2102x1736: 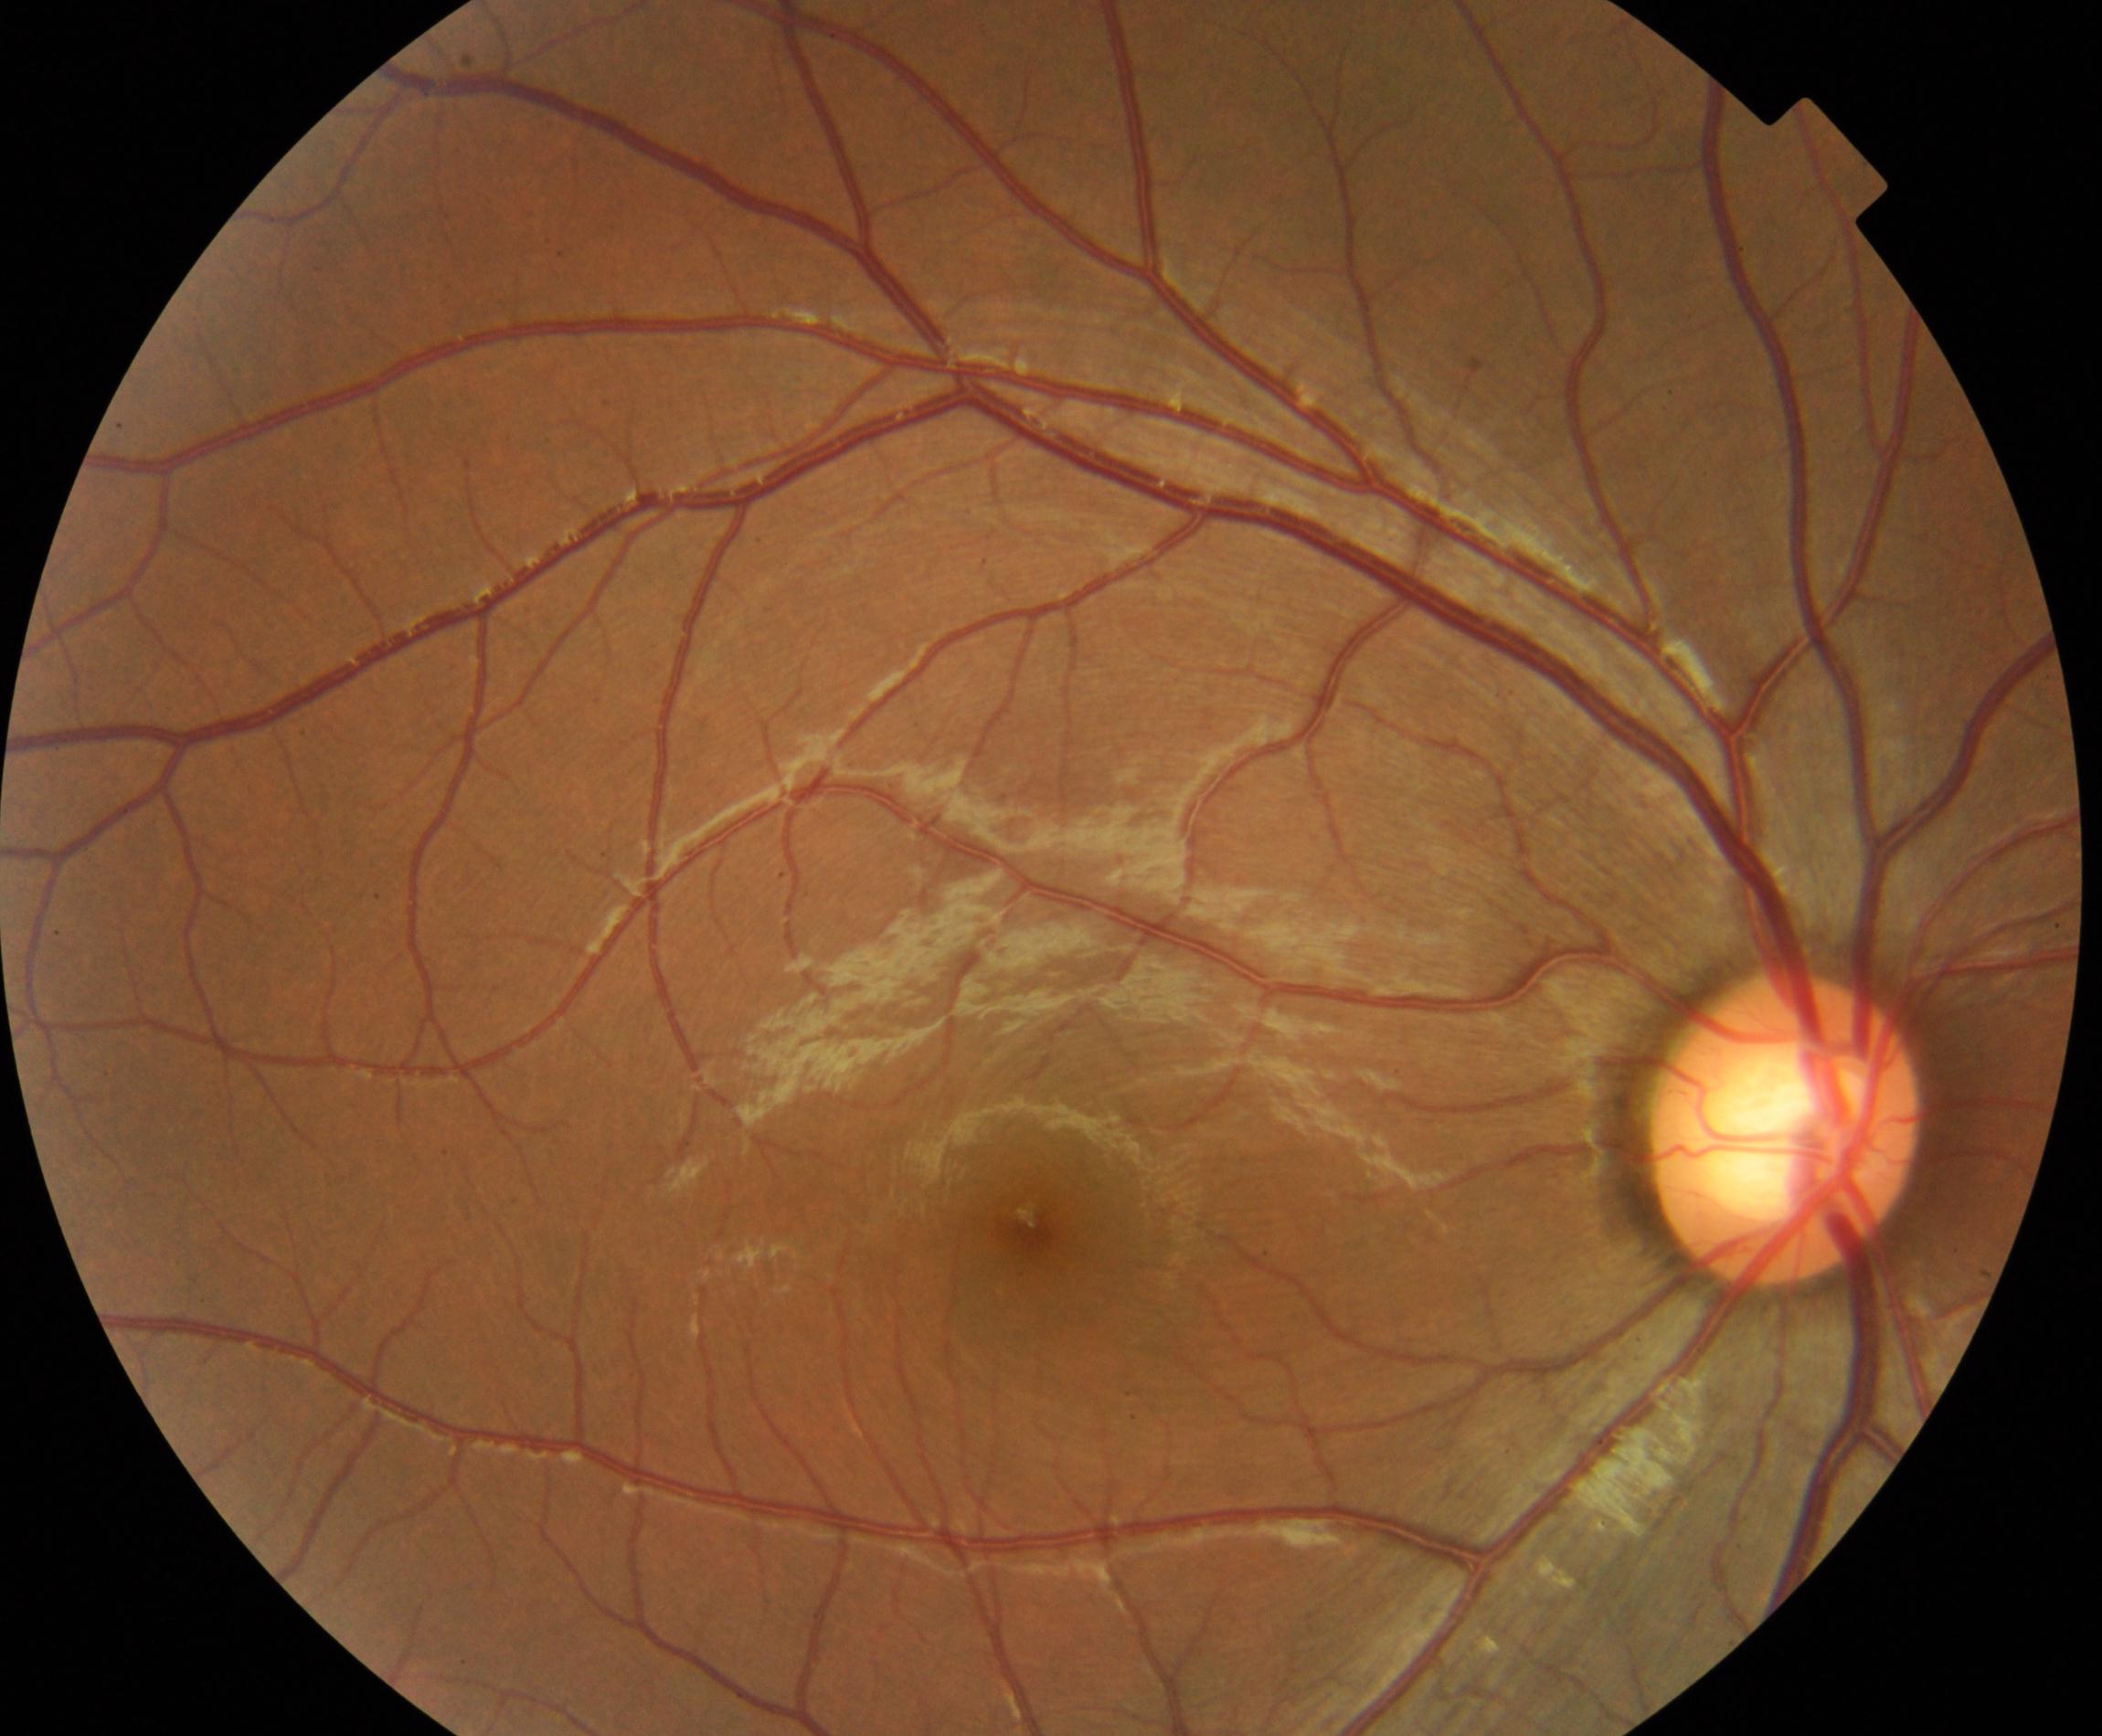 Appearance consistent with large optic cup. Typically showing cup-to-disc ratio greater than 0.5, with a pink neuroretinal rim following the ISNT rule, without notching or bayoneting of vessels.